2212x1672px
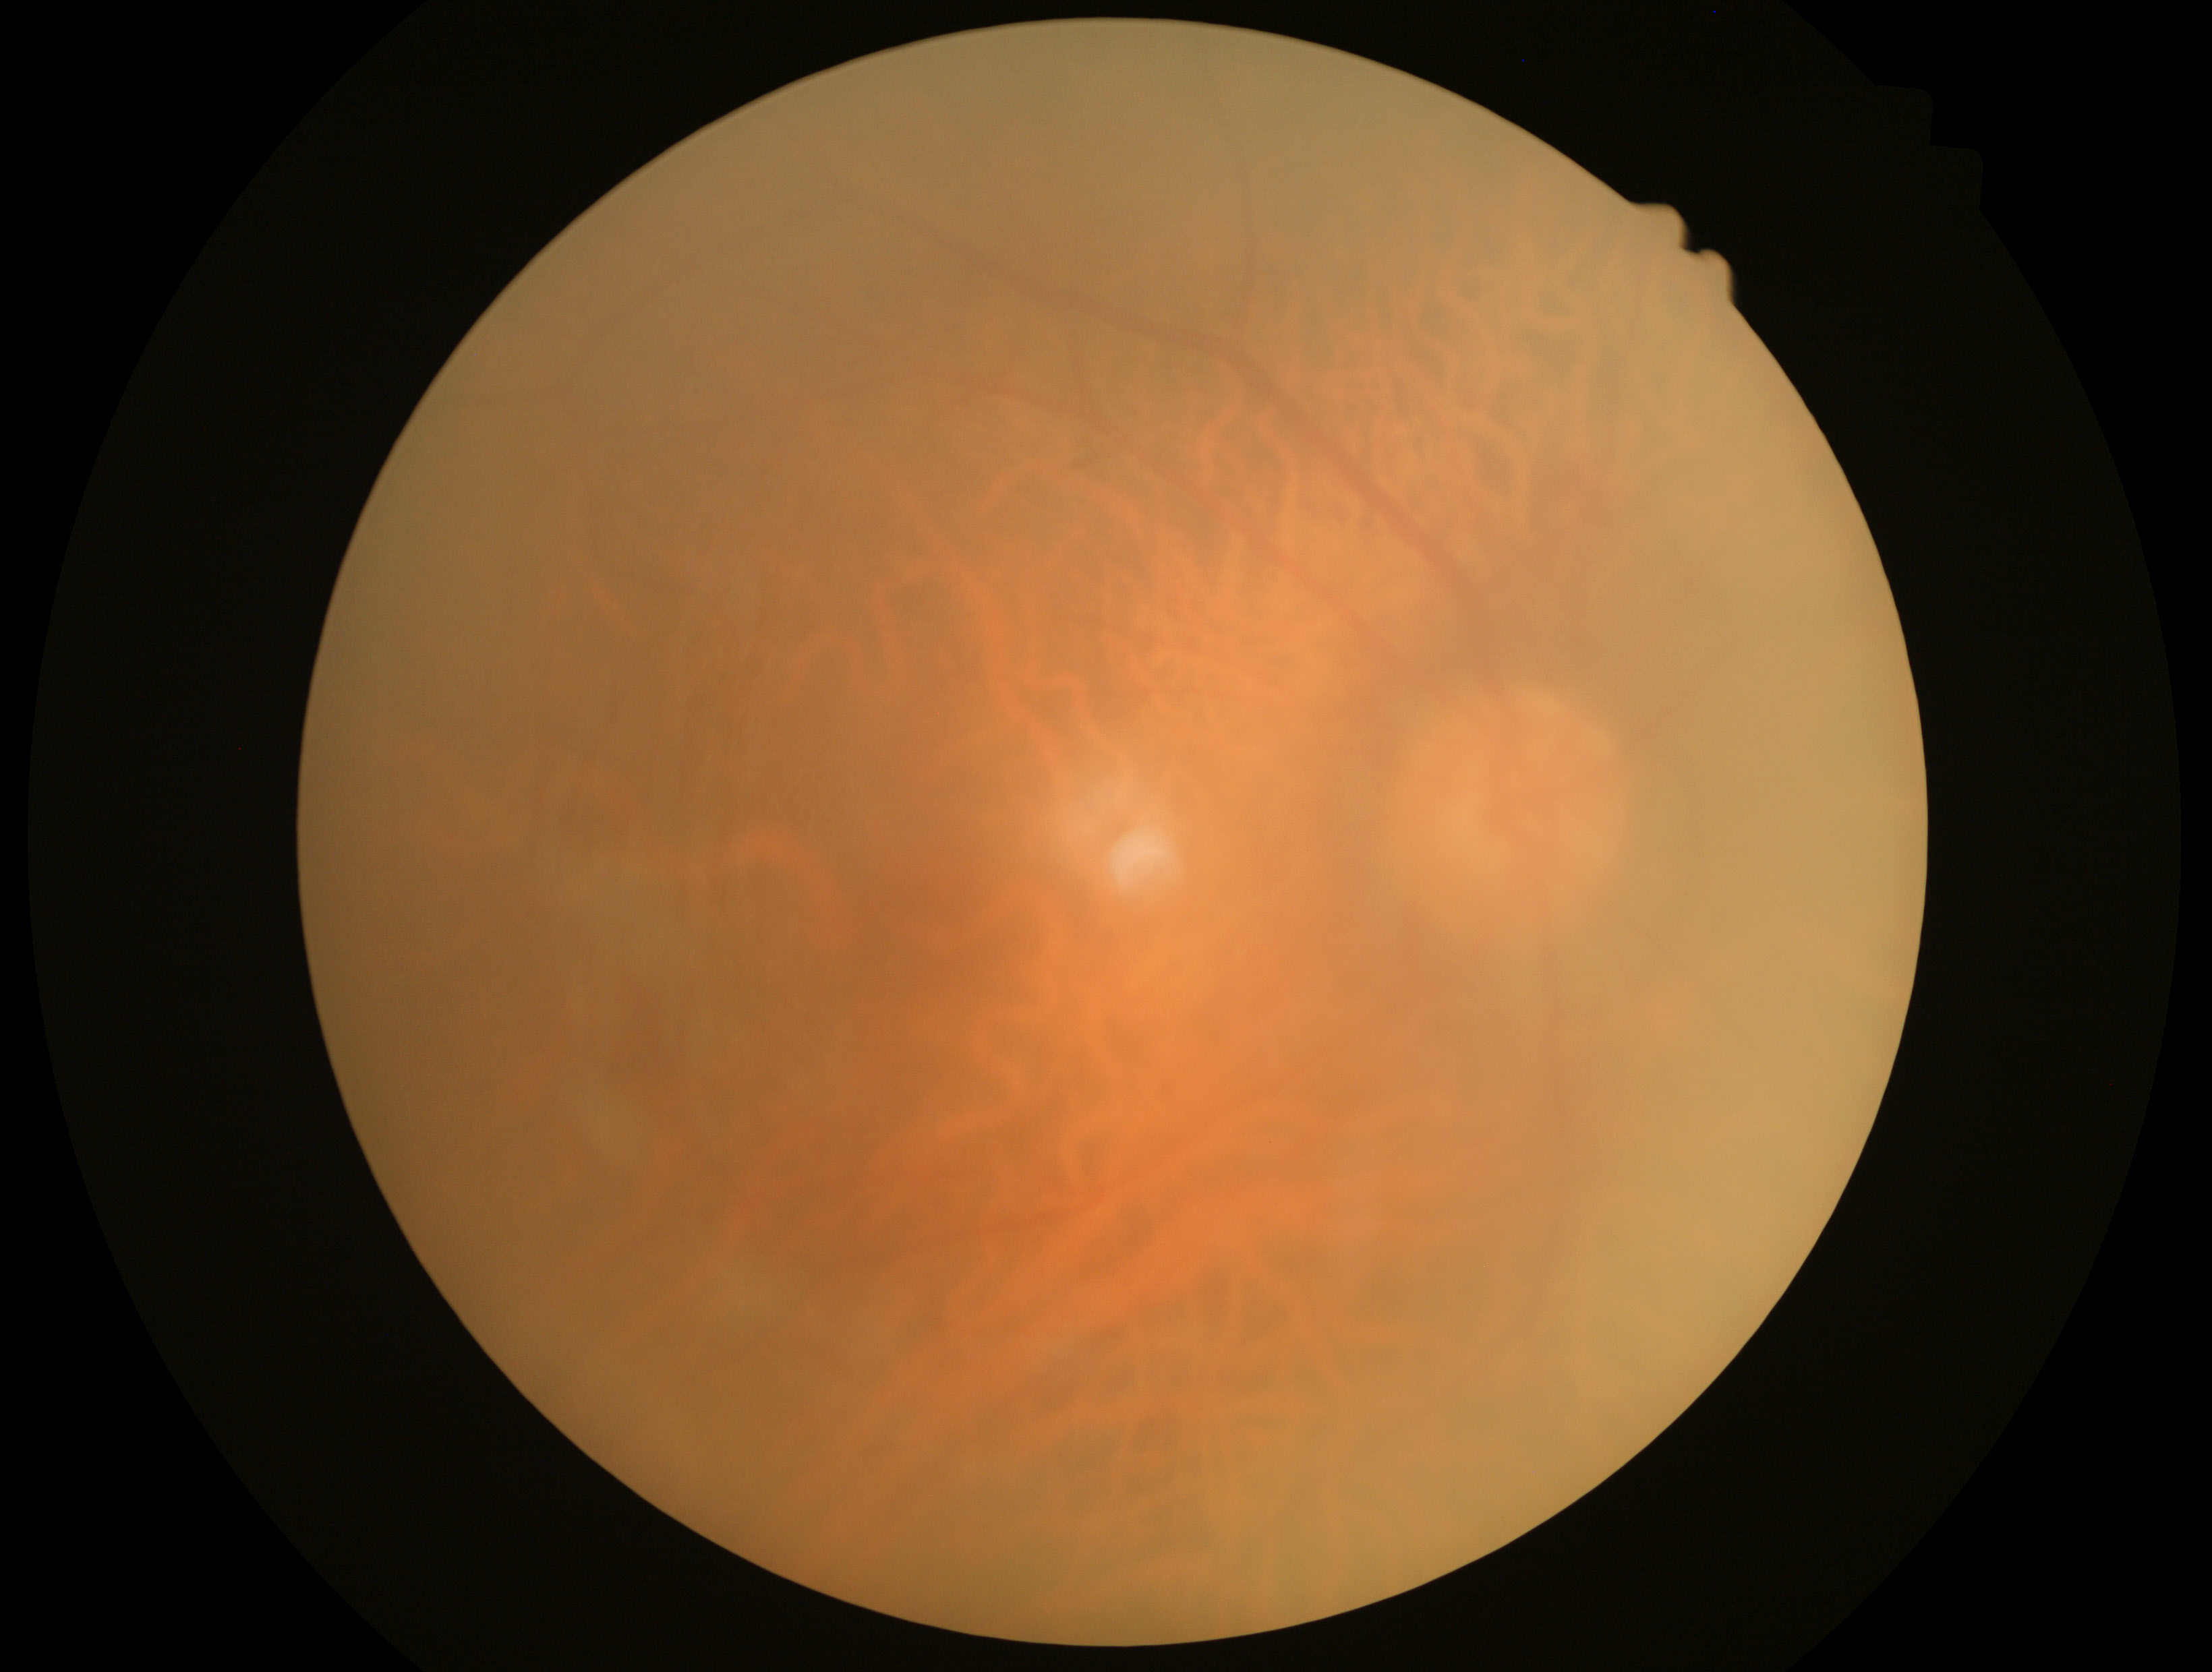
DR grade: 0 (no apparent retinopathy).